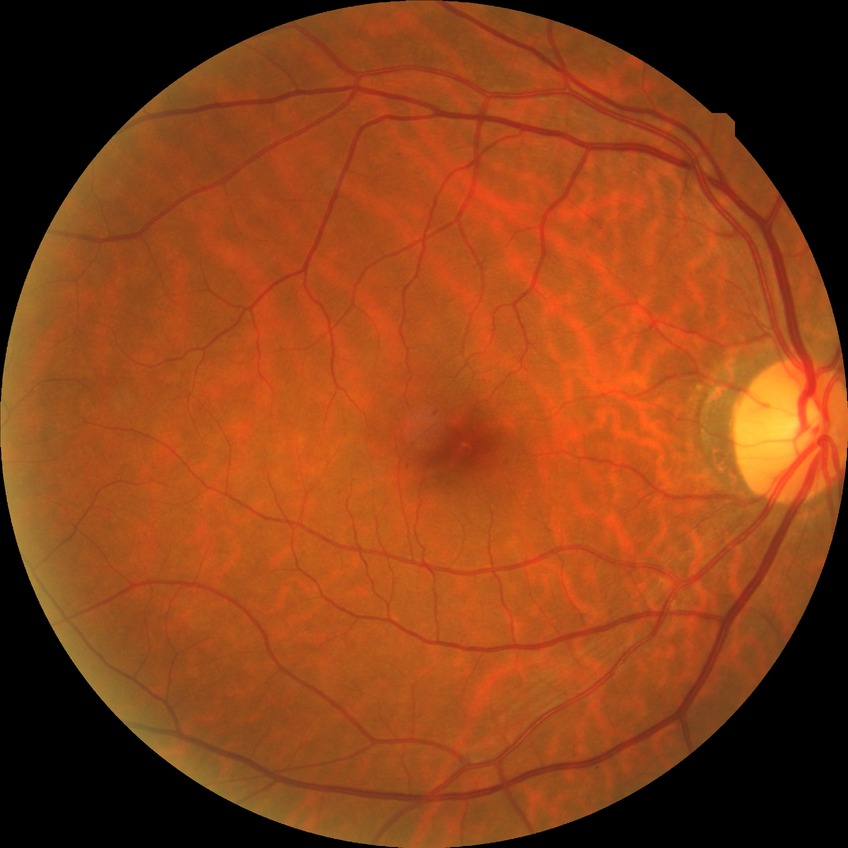
diabetic retinopathy (DR): NDR (no diabetic retinopathy).